Retinal fundus photograph
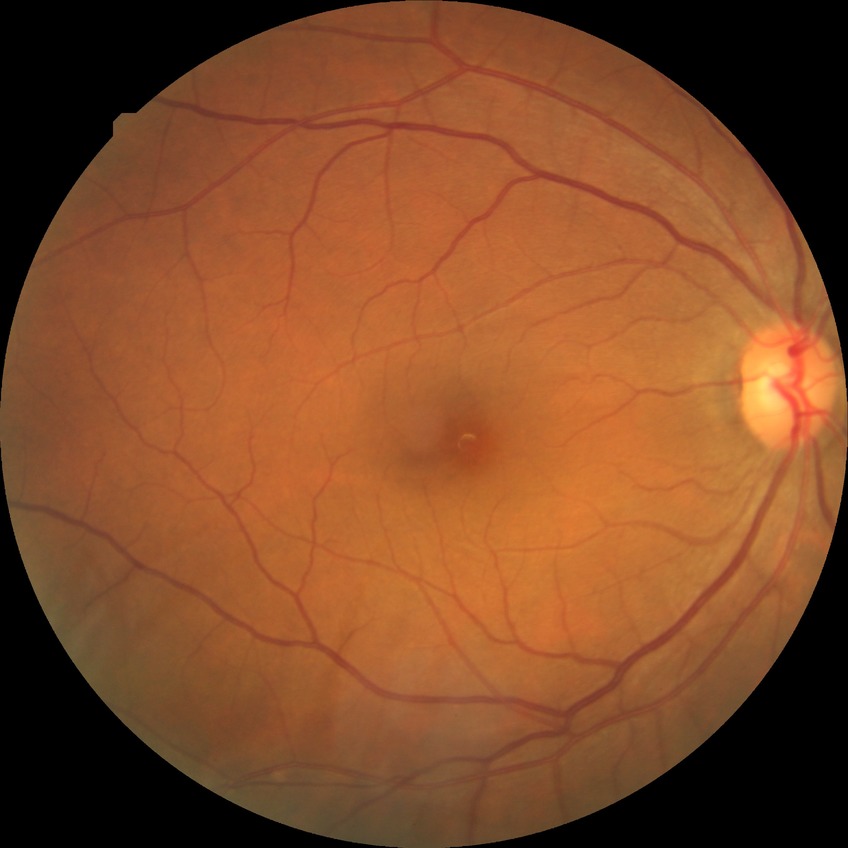 Diabetic retinopathy (DR): NDR (no diabetic retinopathy).